Color fundus photograph · 45-degree field of view · image size 2352x1568.
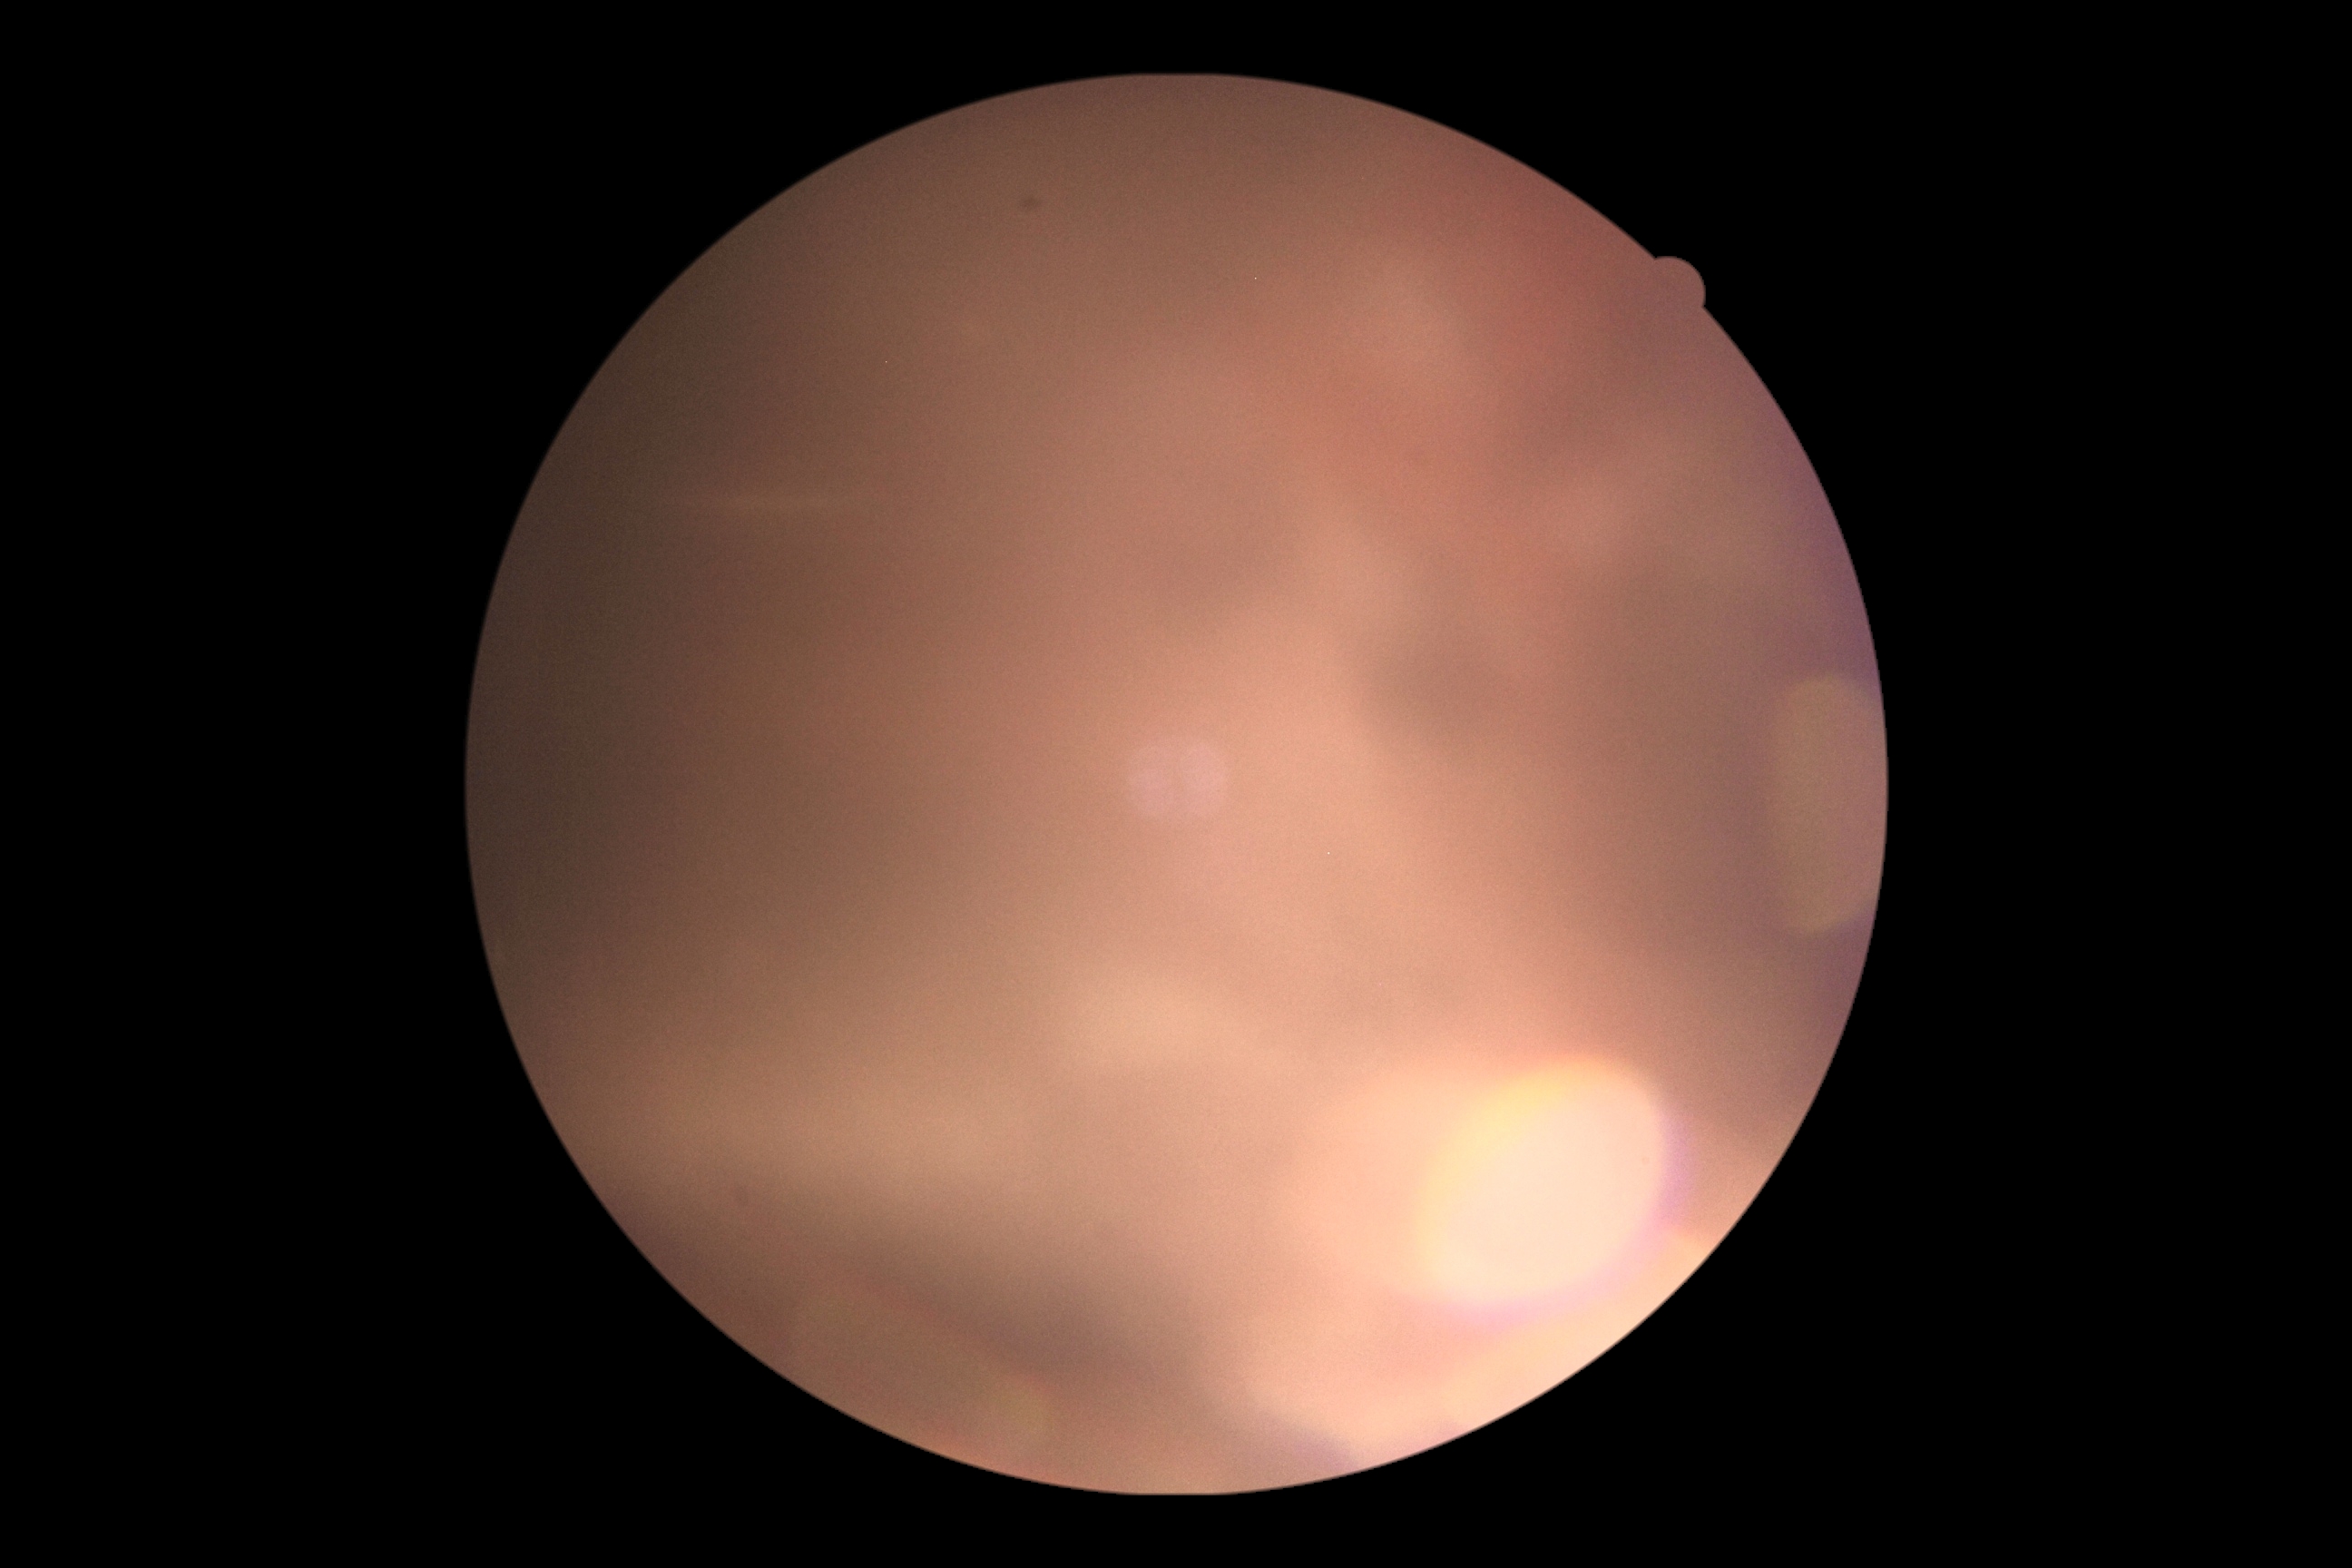

Quality too poor to assess for DR. Diabetic retinopathy (DR) is ungradable due to poor image quality.